Modified Davis classification — 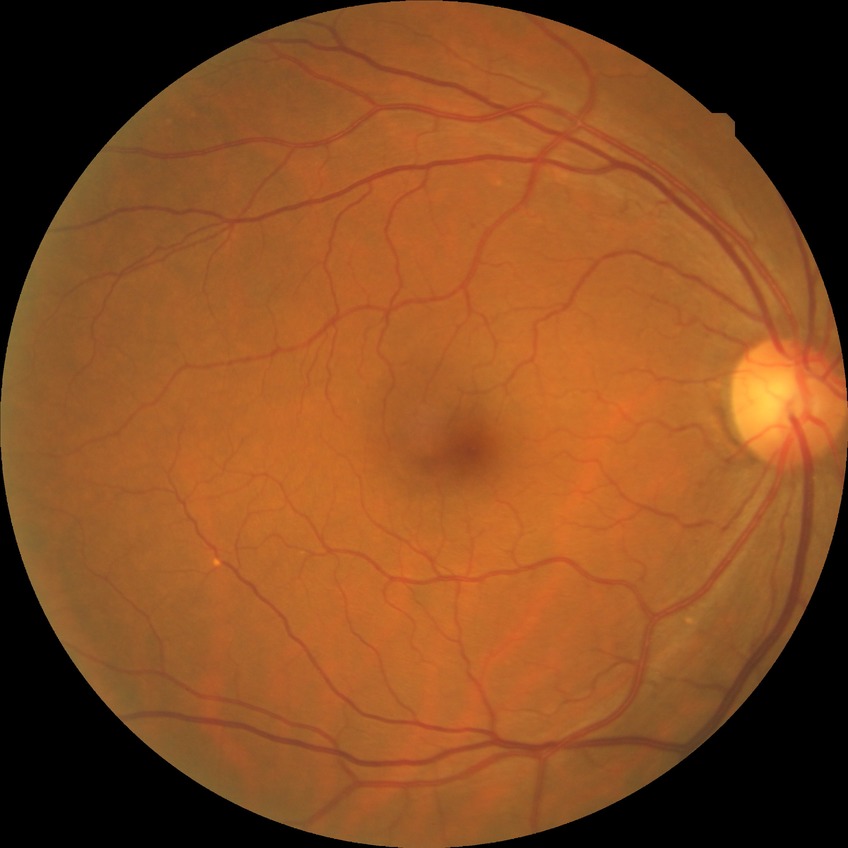 Retinopathy stage: no diabetic retinopathy.